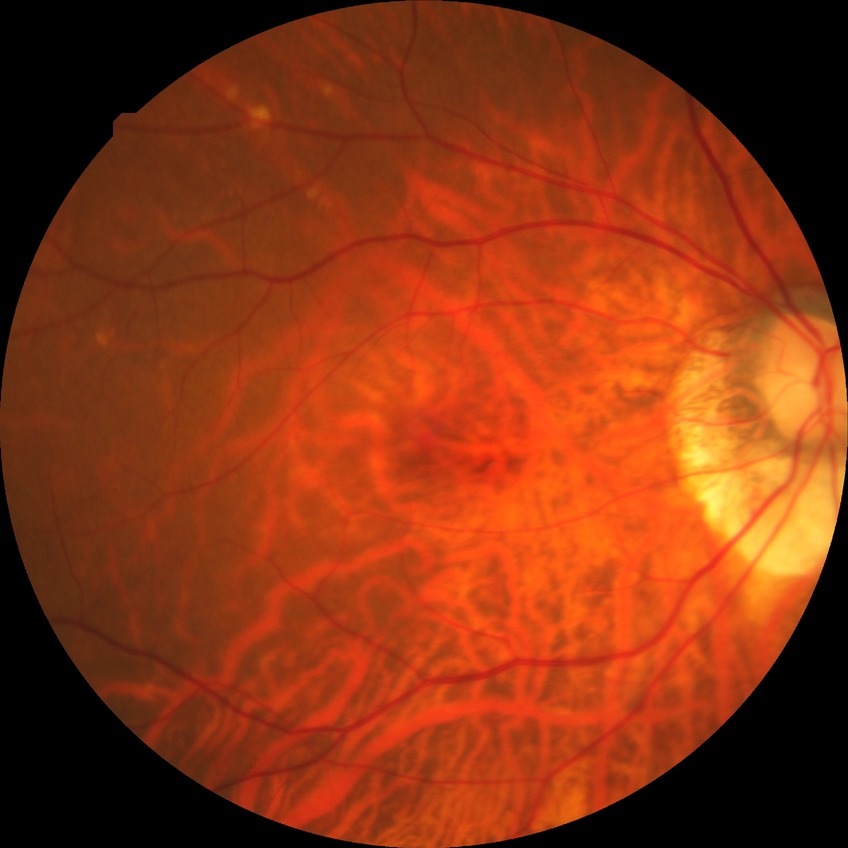

Retinopathy stage: no diabetic retinopathy.